Retinal fundus photograph — 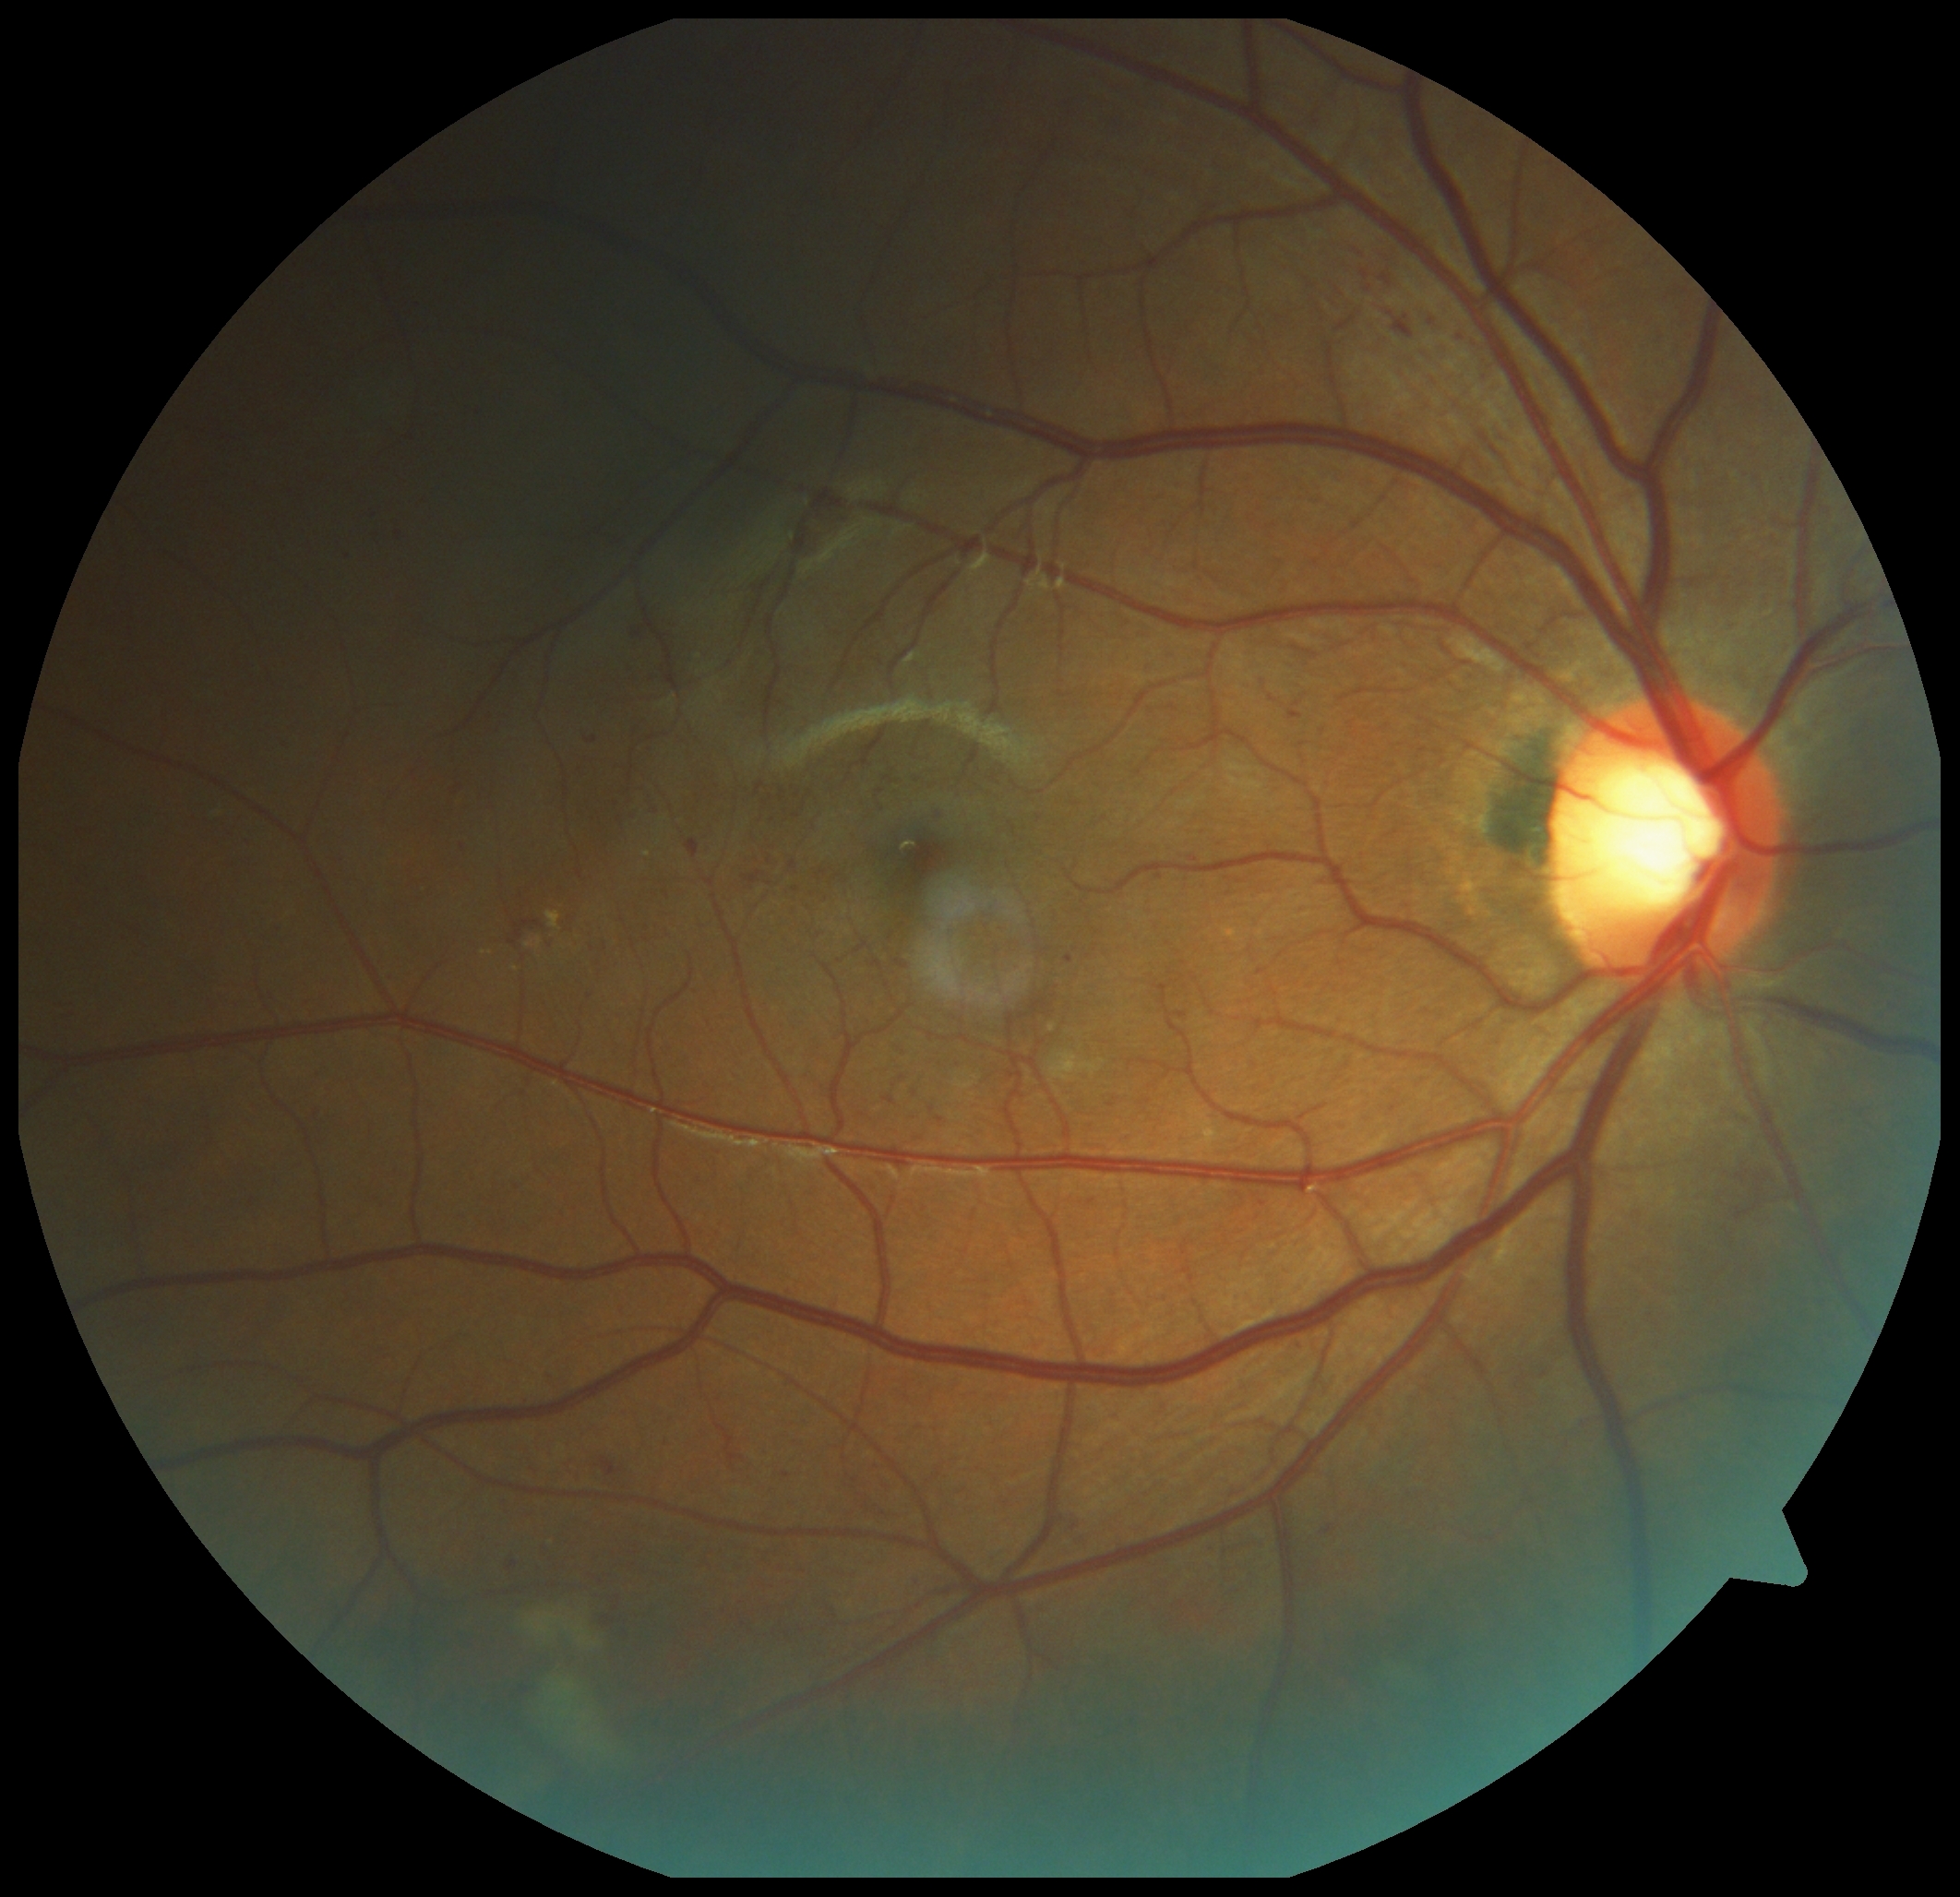
Diabetic retinopathy grade: 2 (moderate NPDR)
A subset of detected lesions:
hard exudates = box=[548, 913, 561, 930]; box=[482, 950, 493, 956]; box=[535, 939, 543, 950]
Hard exudates (small, approximate centers) near <point>517, 969</point>; <point>528, 945</point>
hemorrhages = box=[601, 1458, 621, 1477]; box=[508, 941, 518, 947]; box=[1394, 316, 1415, 340]; box=[514, 920, 546, 939]
microaneurysms (partial) = box=[1153, 867, 1166, 877]; box=[508, 1561, 518, 1570]; box=[1362, 271, 1369, 280]; box=[896, 960, 907, 969]; box=[474, 409, 482, 418]; box=[345, 552, 354, 561]; box=[373, 535, 384, 539]; box=[447, 787, 463, 800]; box=[817, 871, 828, 881]; box=[744, 872, 764, 885]; box=[1356, 240, 1364, 249]; box=[606, 1619, 614, 1626]
Microaneurysms (small, approximate centers) near <point>1369, 290</point>; <point>797, 890</point>; <point>794, 865</point>
soft exudates = box=[521, 1590, 630, 1778]